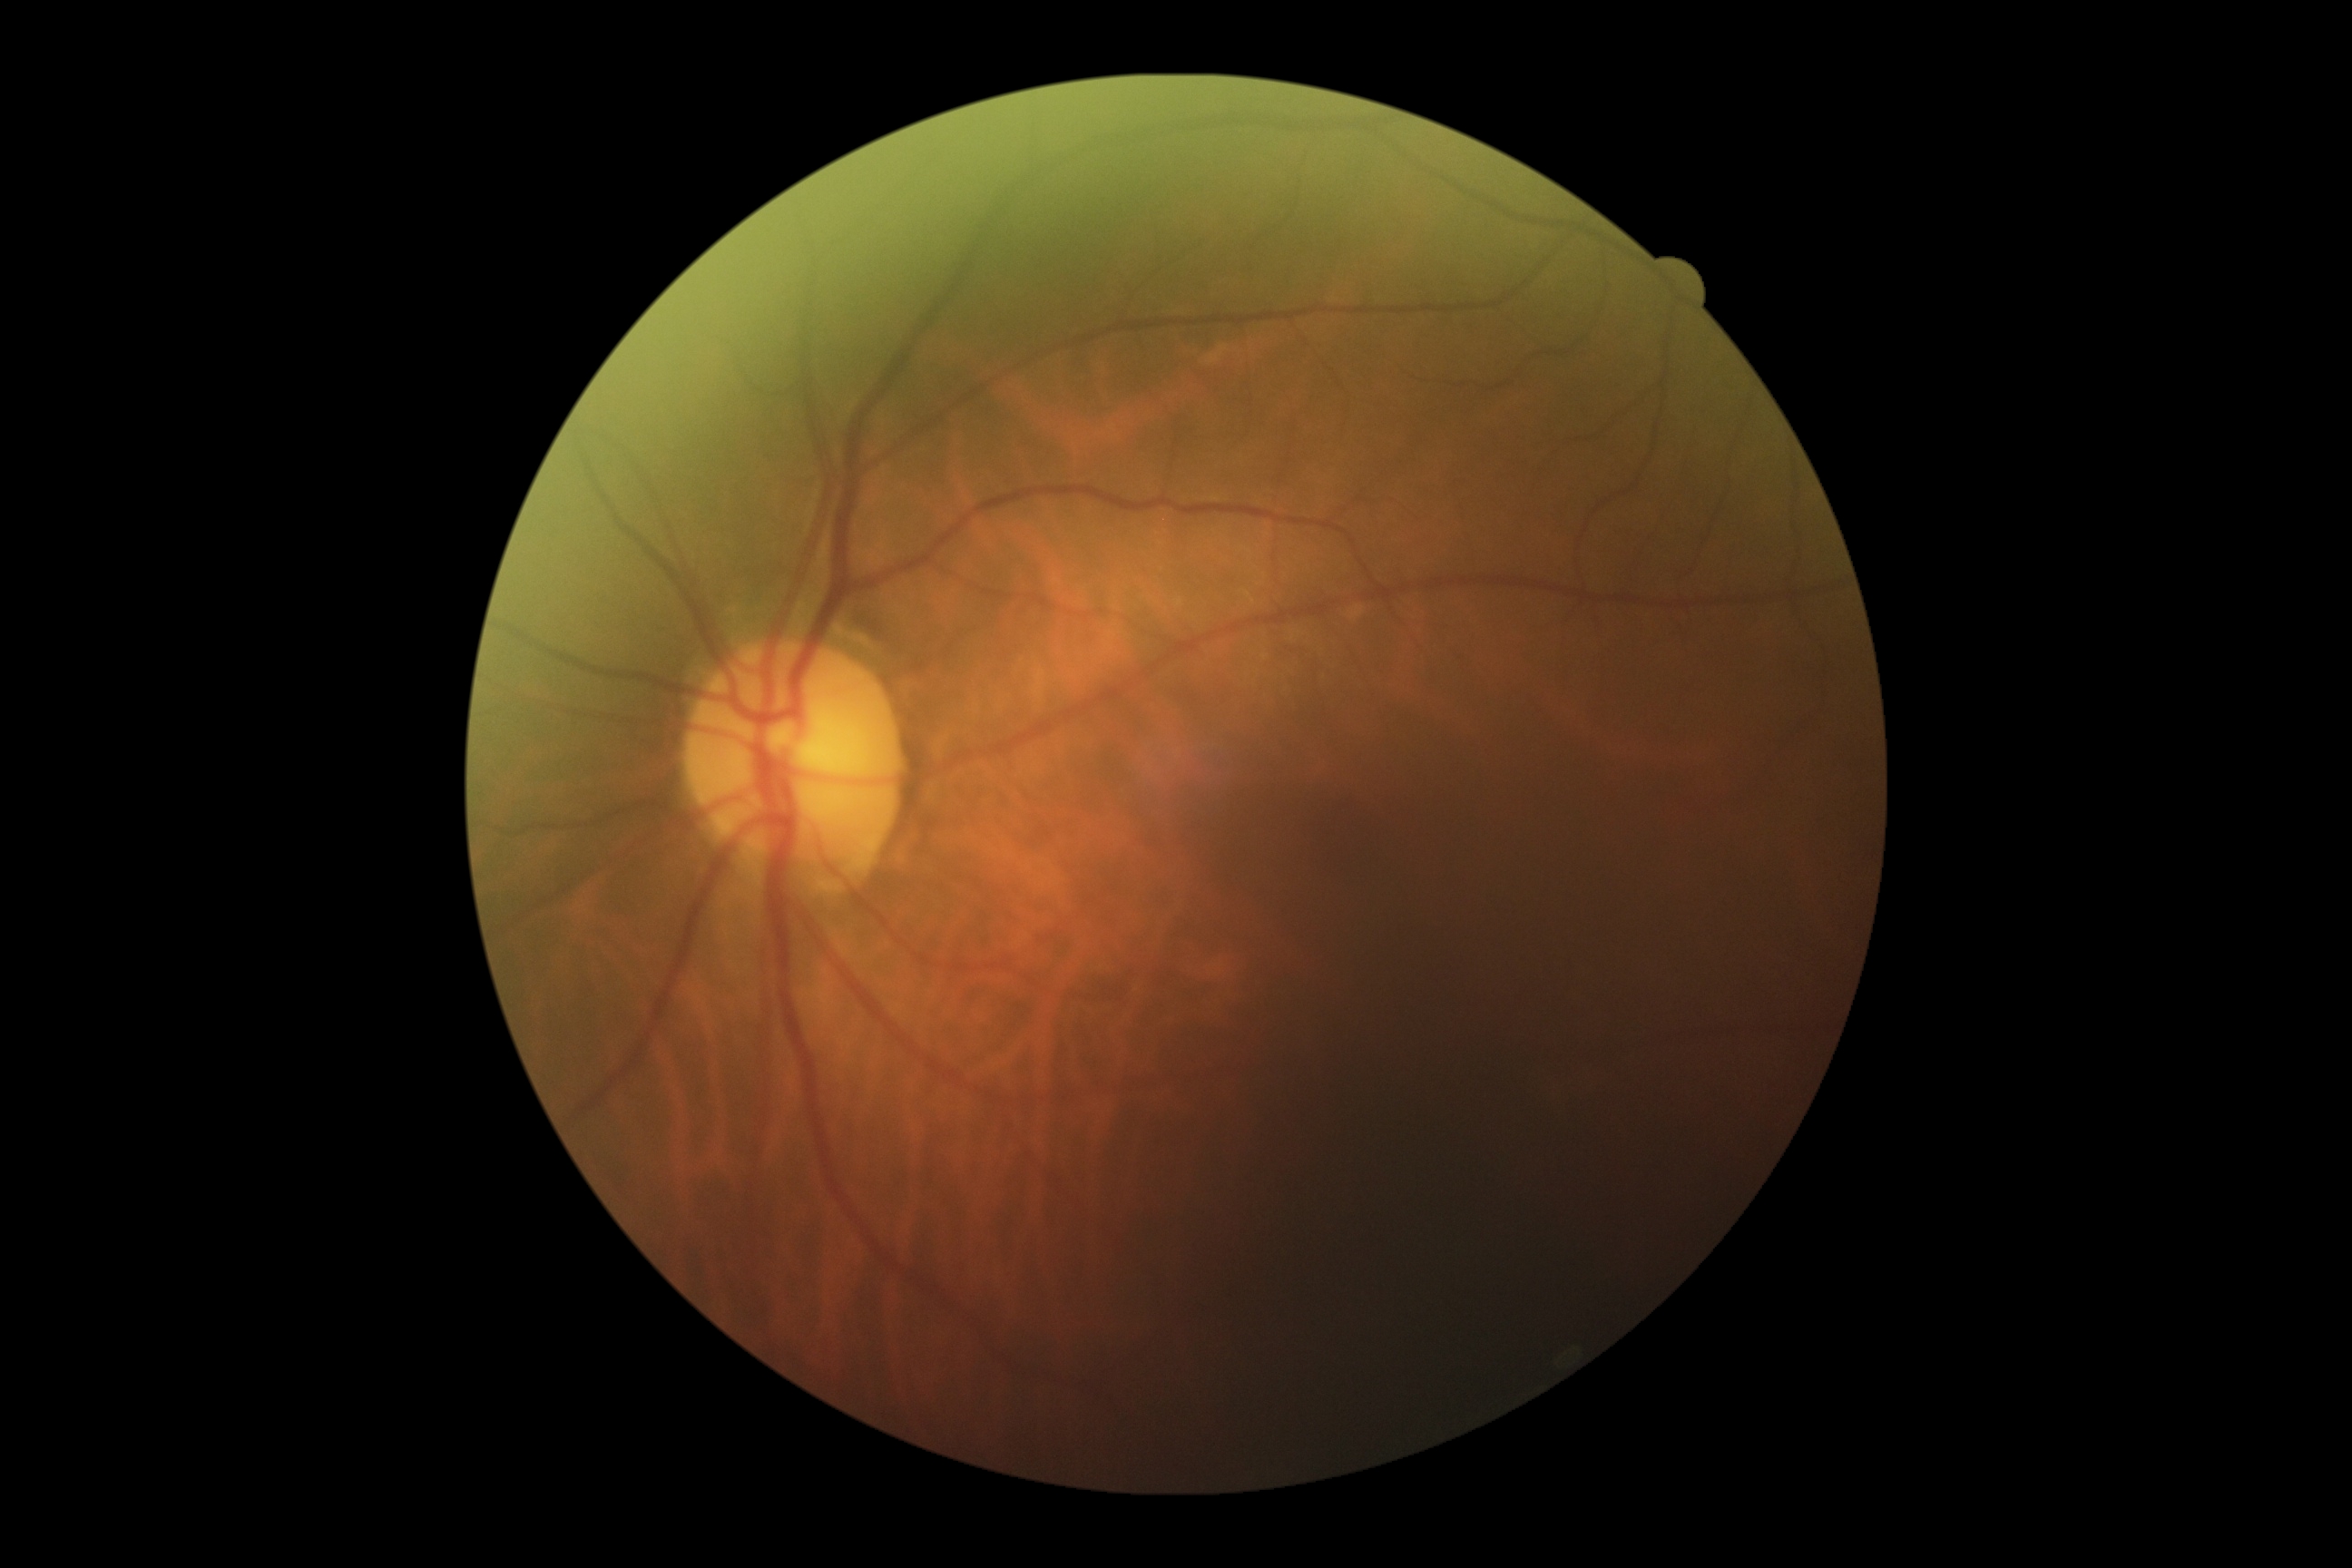

dr_impression: no signs of DR
dr_grade: grade 0